UWF retinal mosaic: 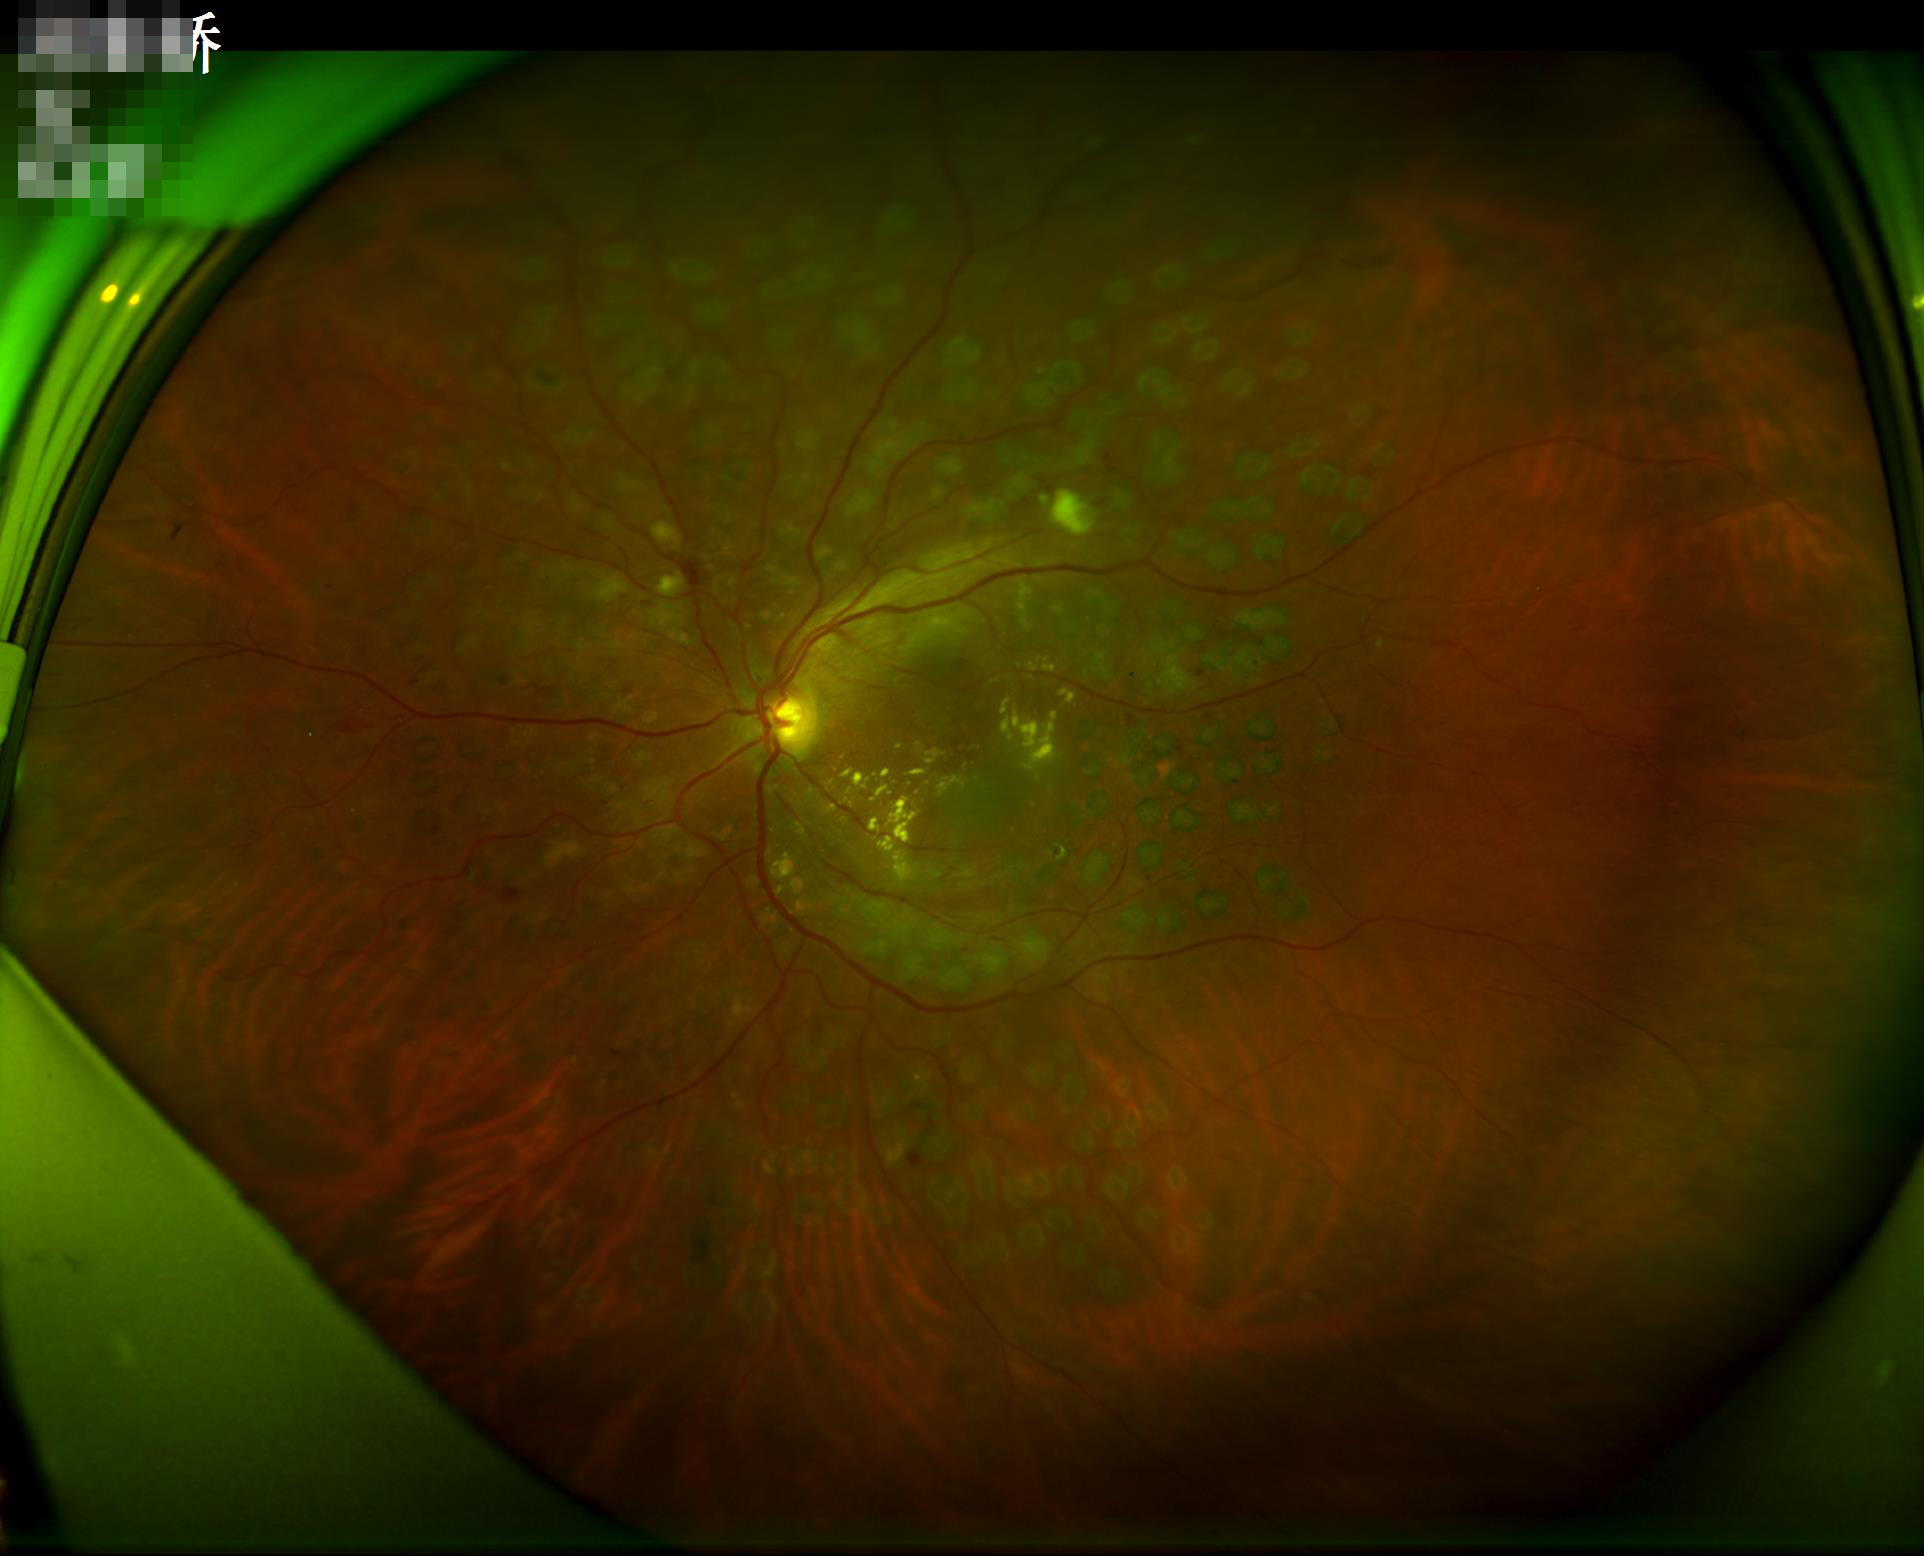
Contrast = wide intensity range, structures distinguishable | Focus = clear with no noticeable blur | Illumination = even and well-balanced | Overall = good, gradable.